Camera: Natus RetCam Envision (130° FOV) · infant wide-field retinal image: 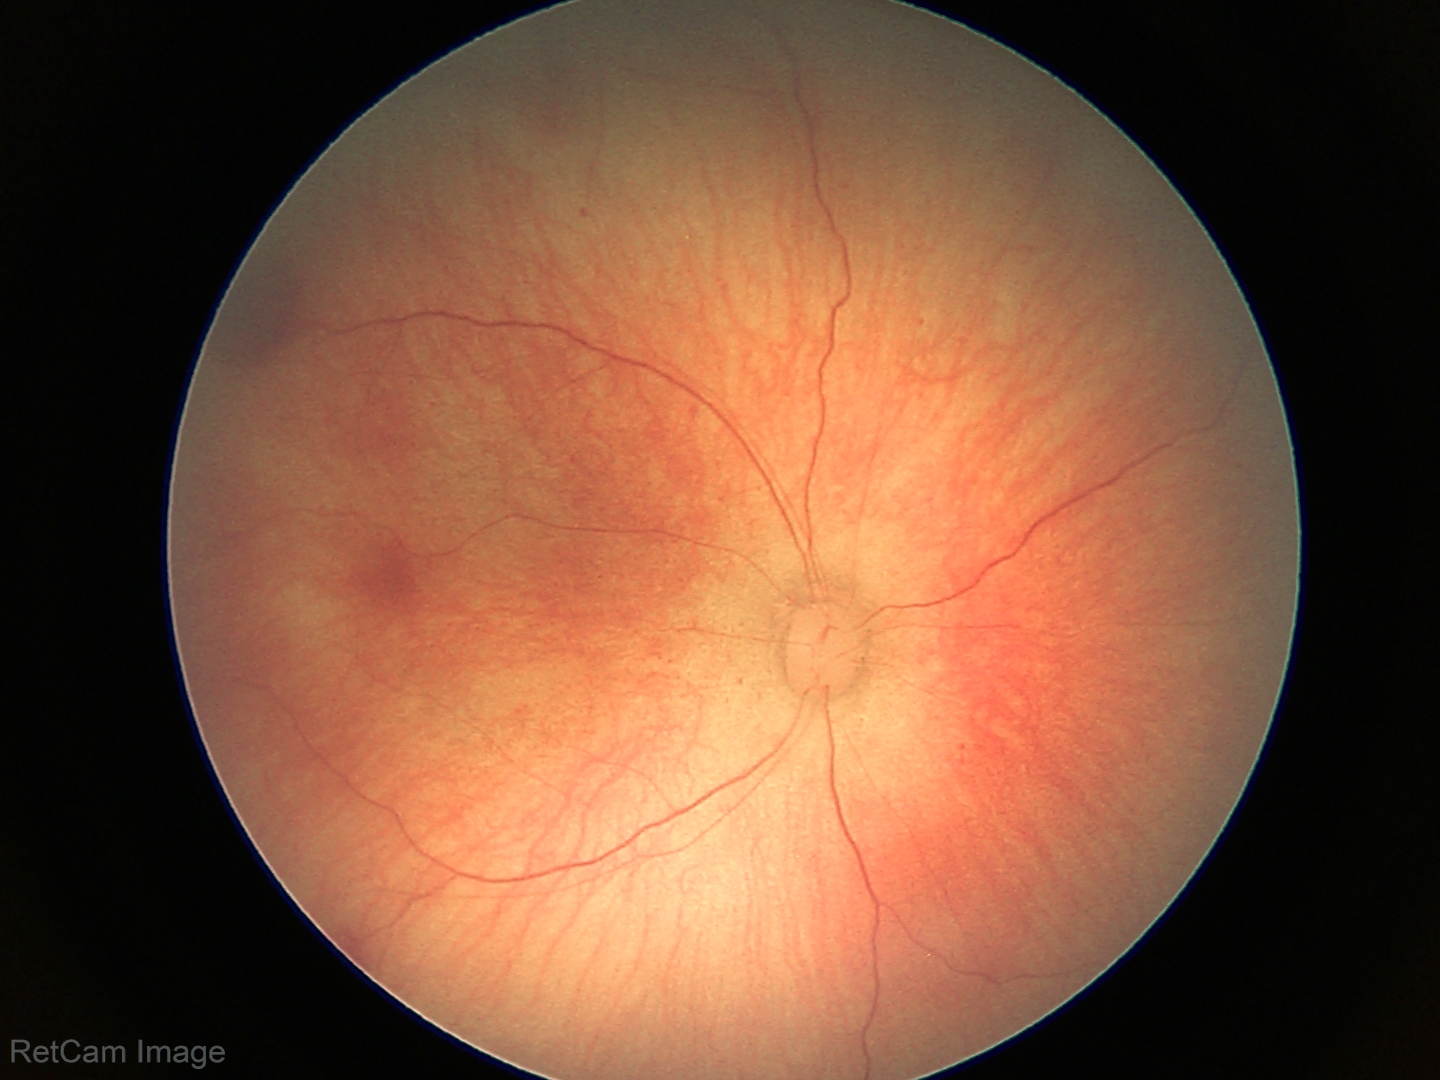
Series diagnosed as retinal hemorrhages.